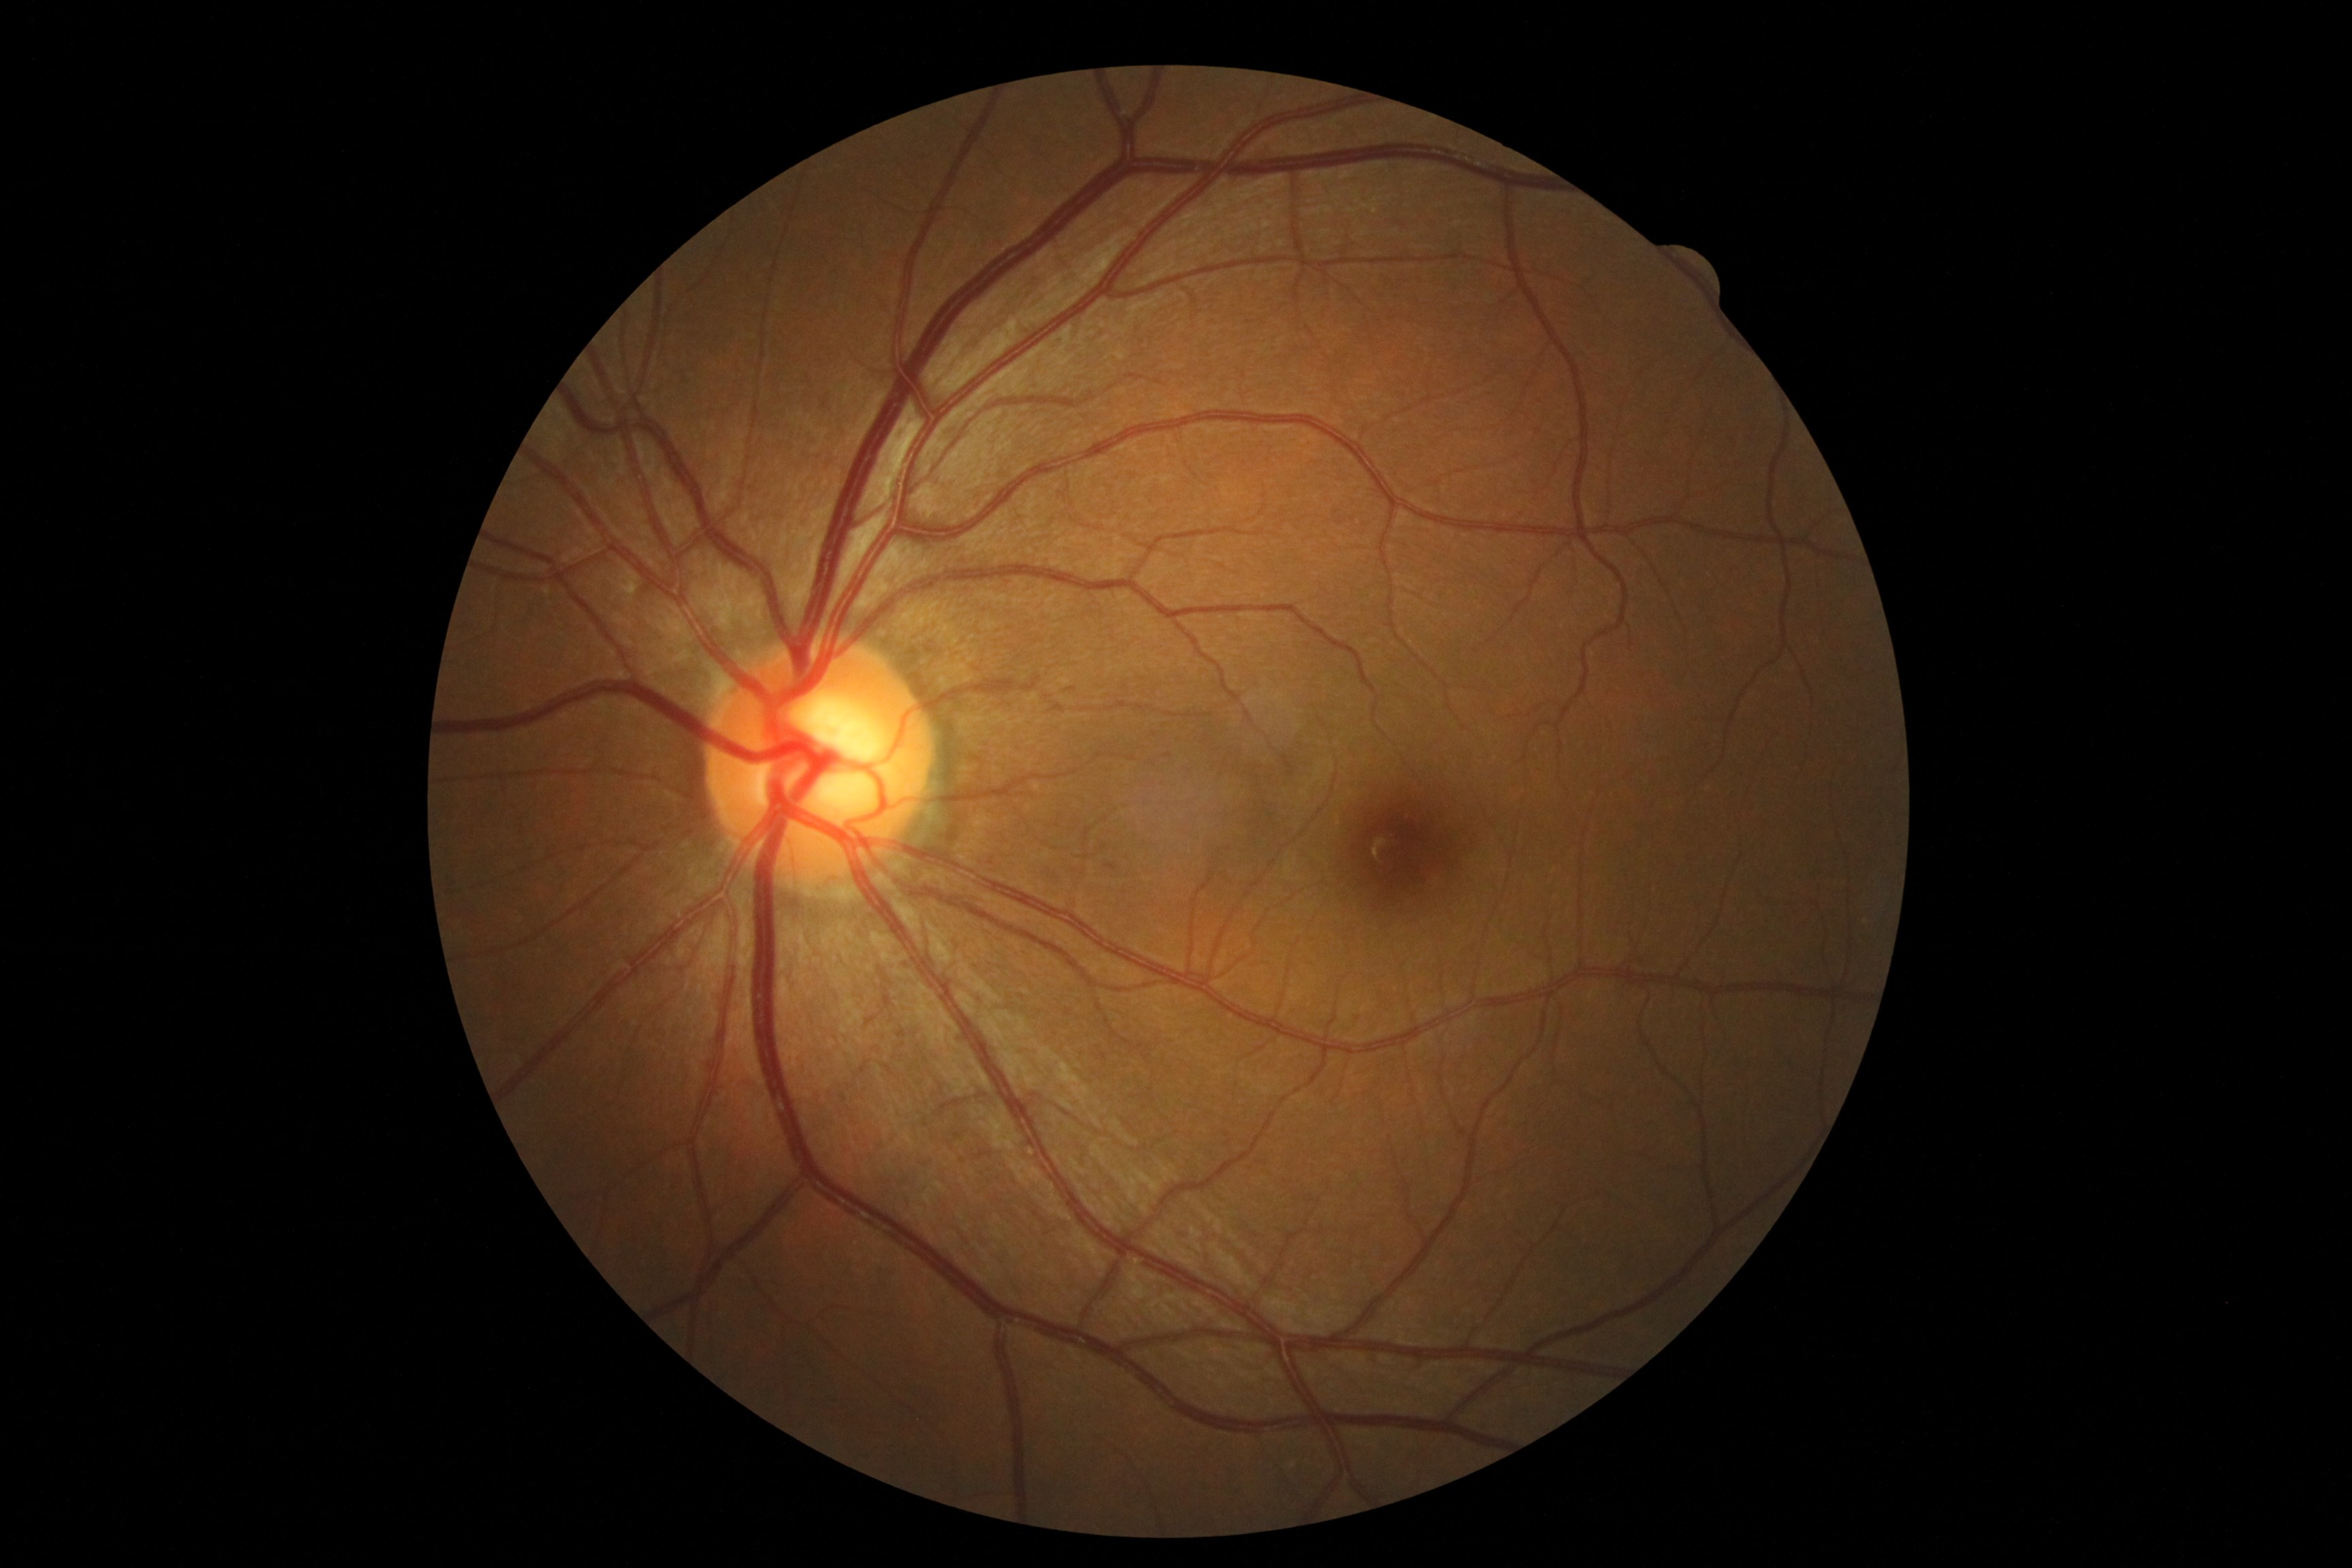

- DR grade — 0 (no apparent retinopathy)